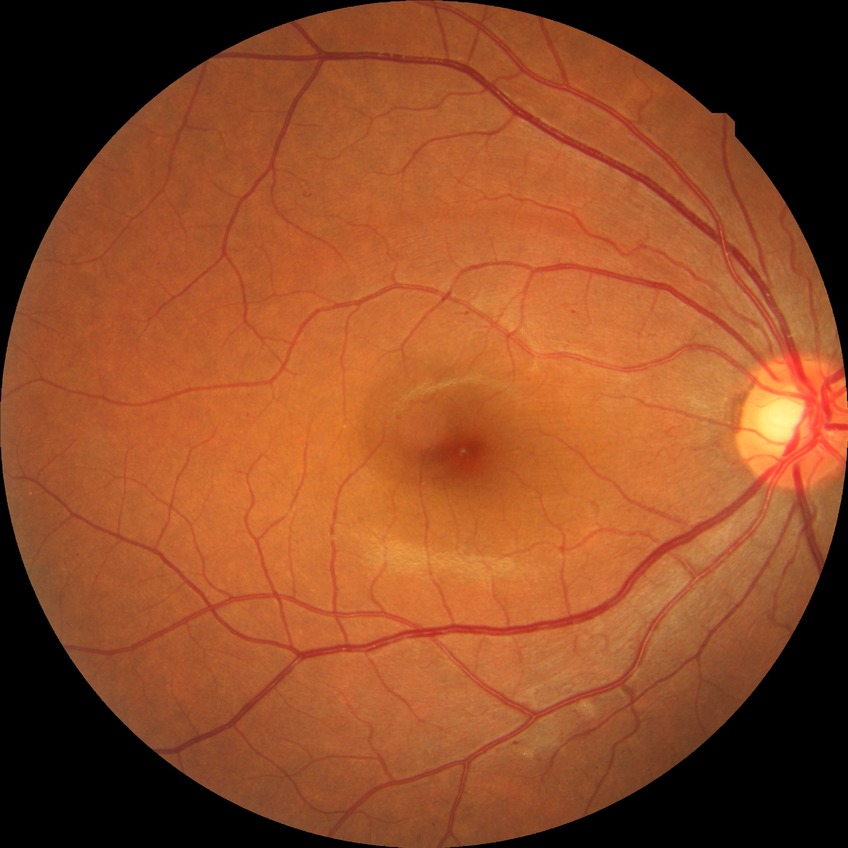 DR grade: SDR.